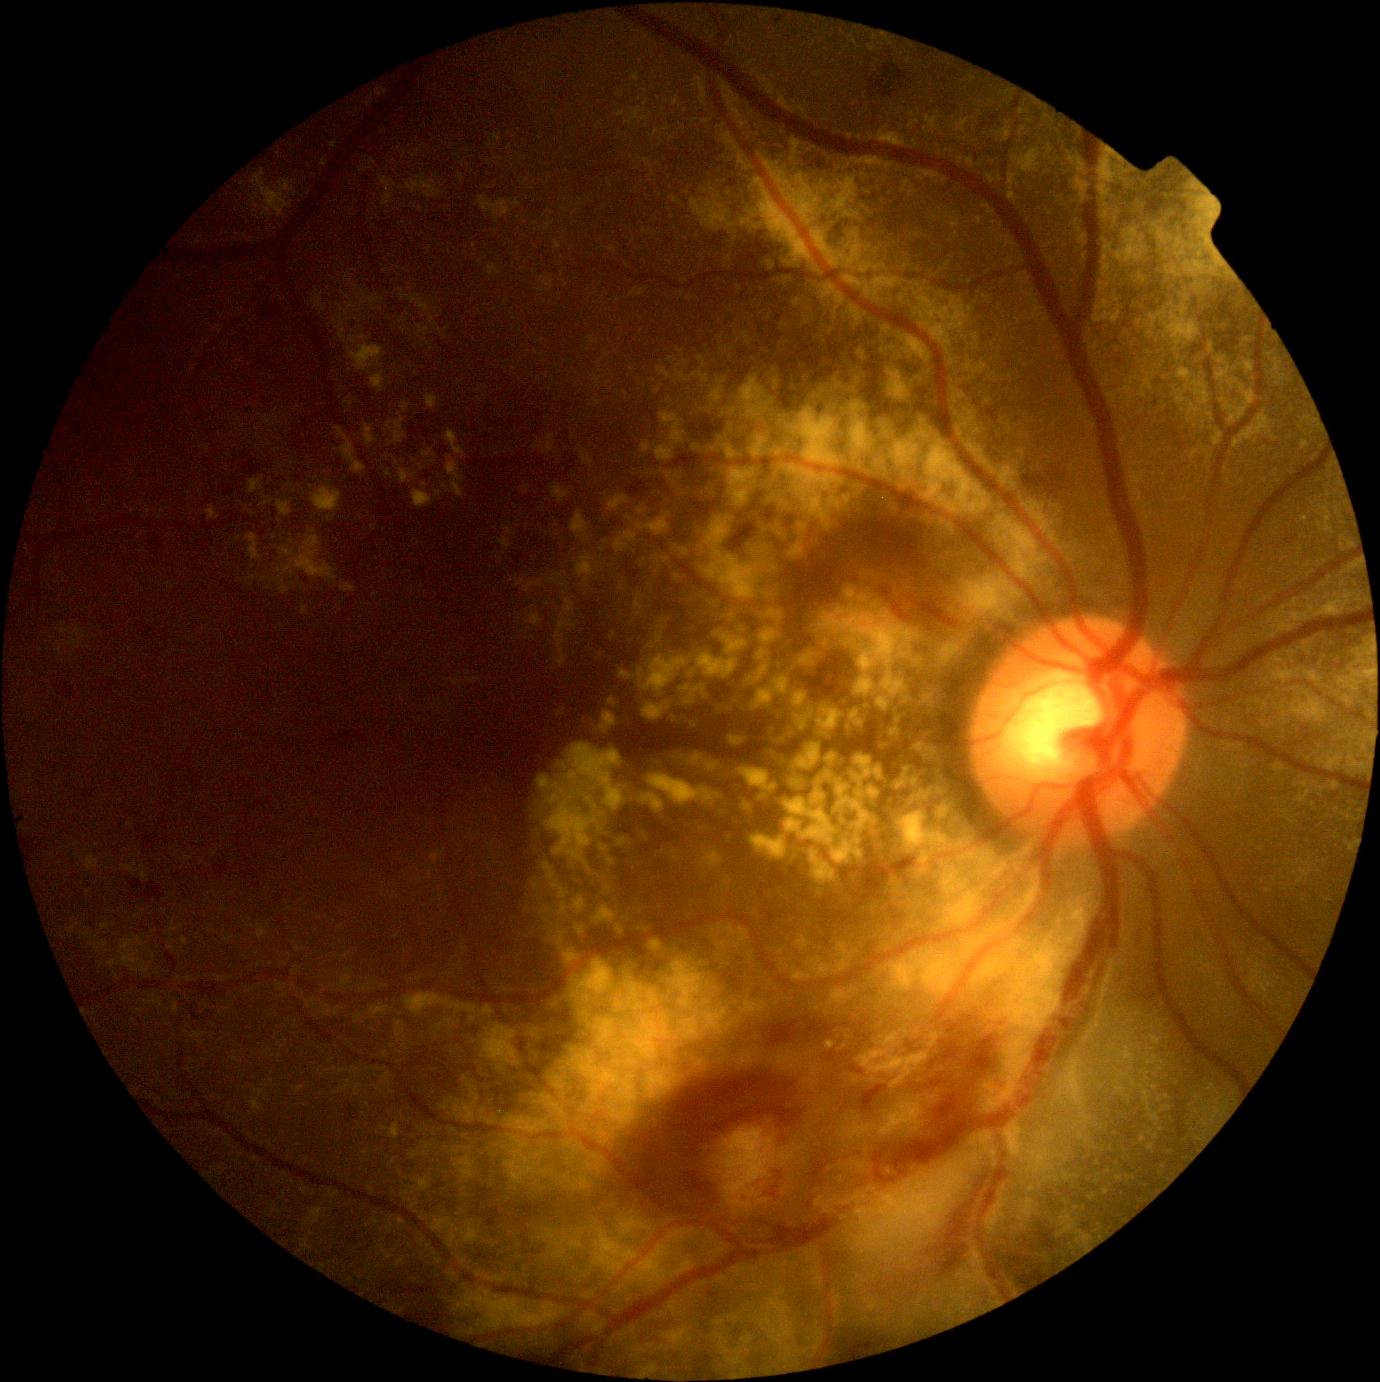 dr_grade: PDR (grade 4)